FOV: 45 degrees · color fundus image · acquired with a NIDEK AFC-230 · no pharmacologic dilation · graded on the modified Davis scale · 848x848px
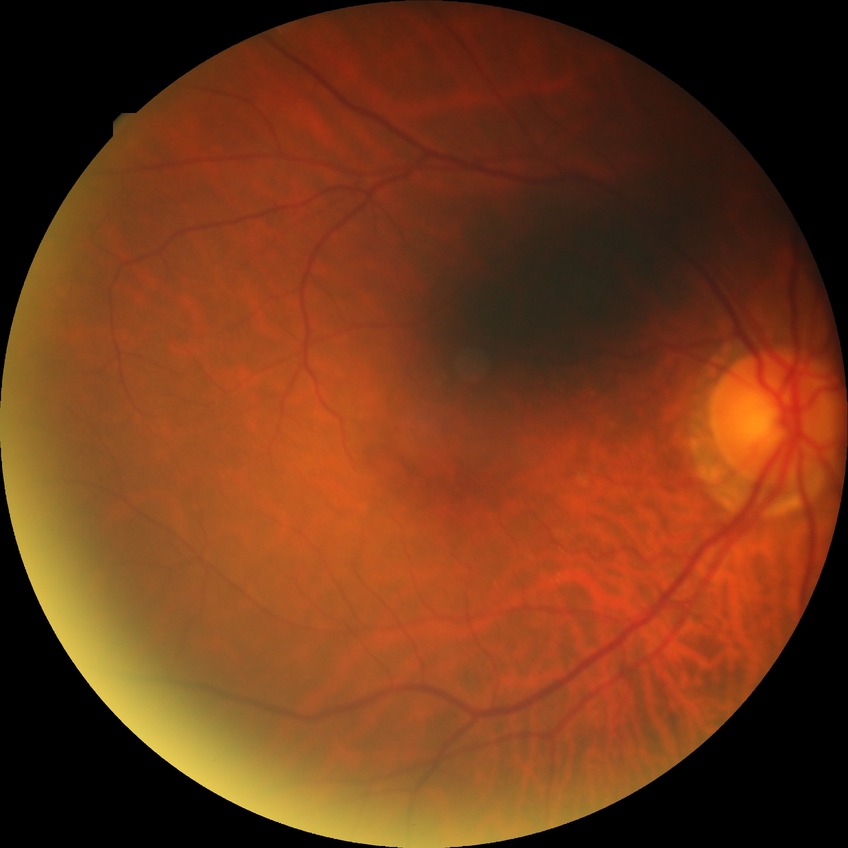
Davis DR grade is NDR. No signs of diabetic retinopathy.